1932x1932px. 45° field of view:
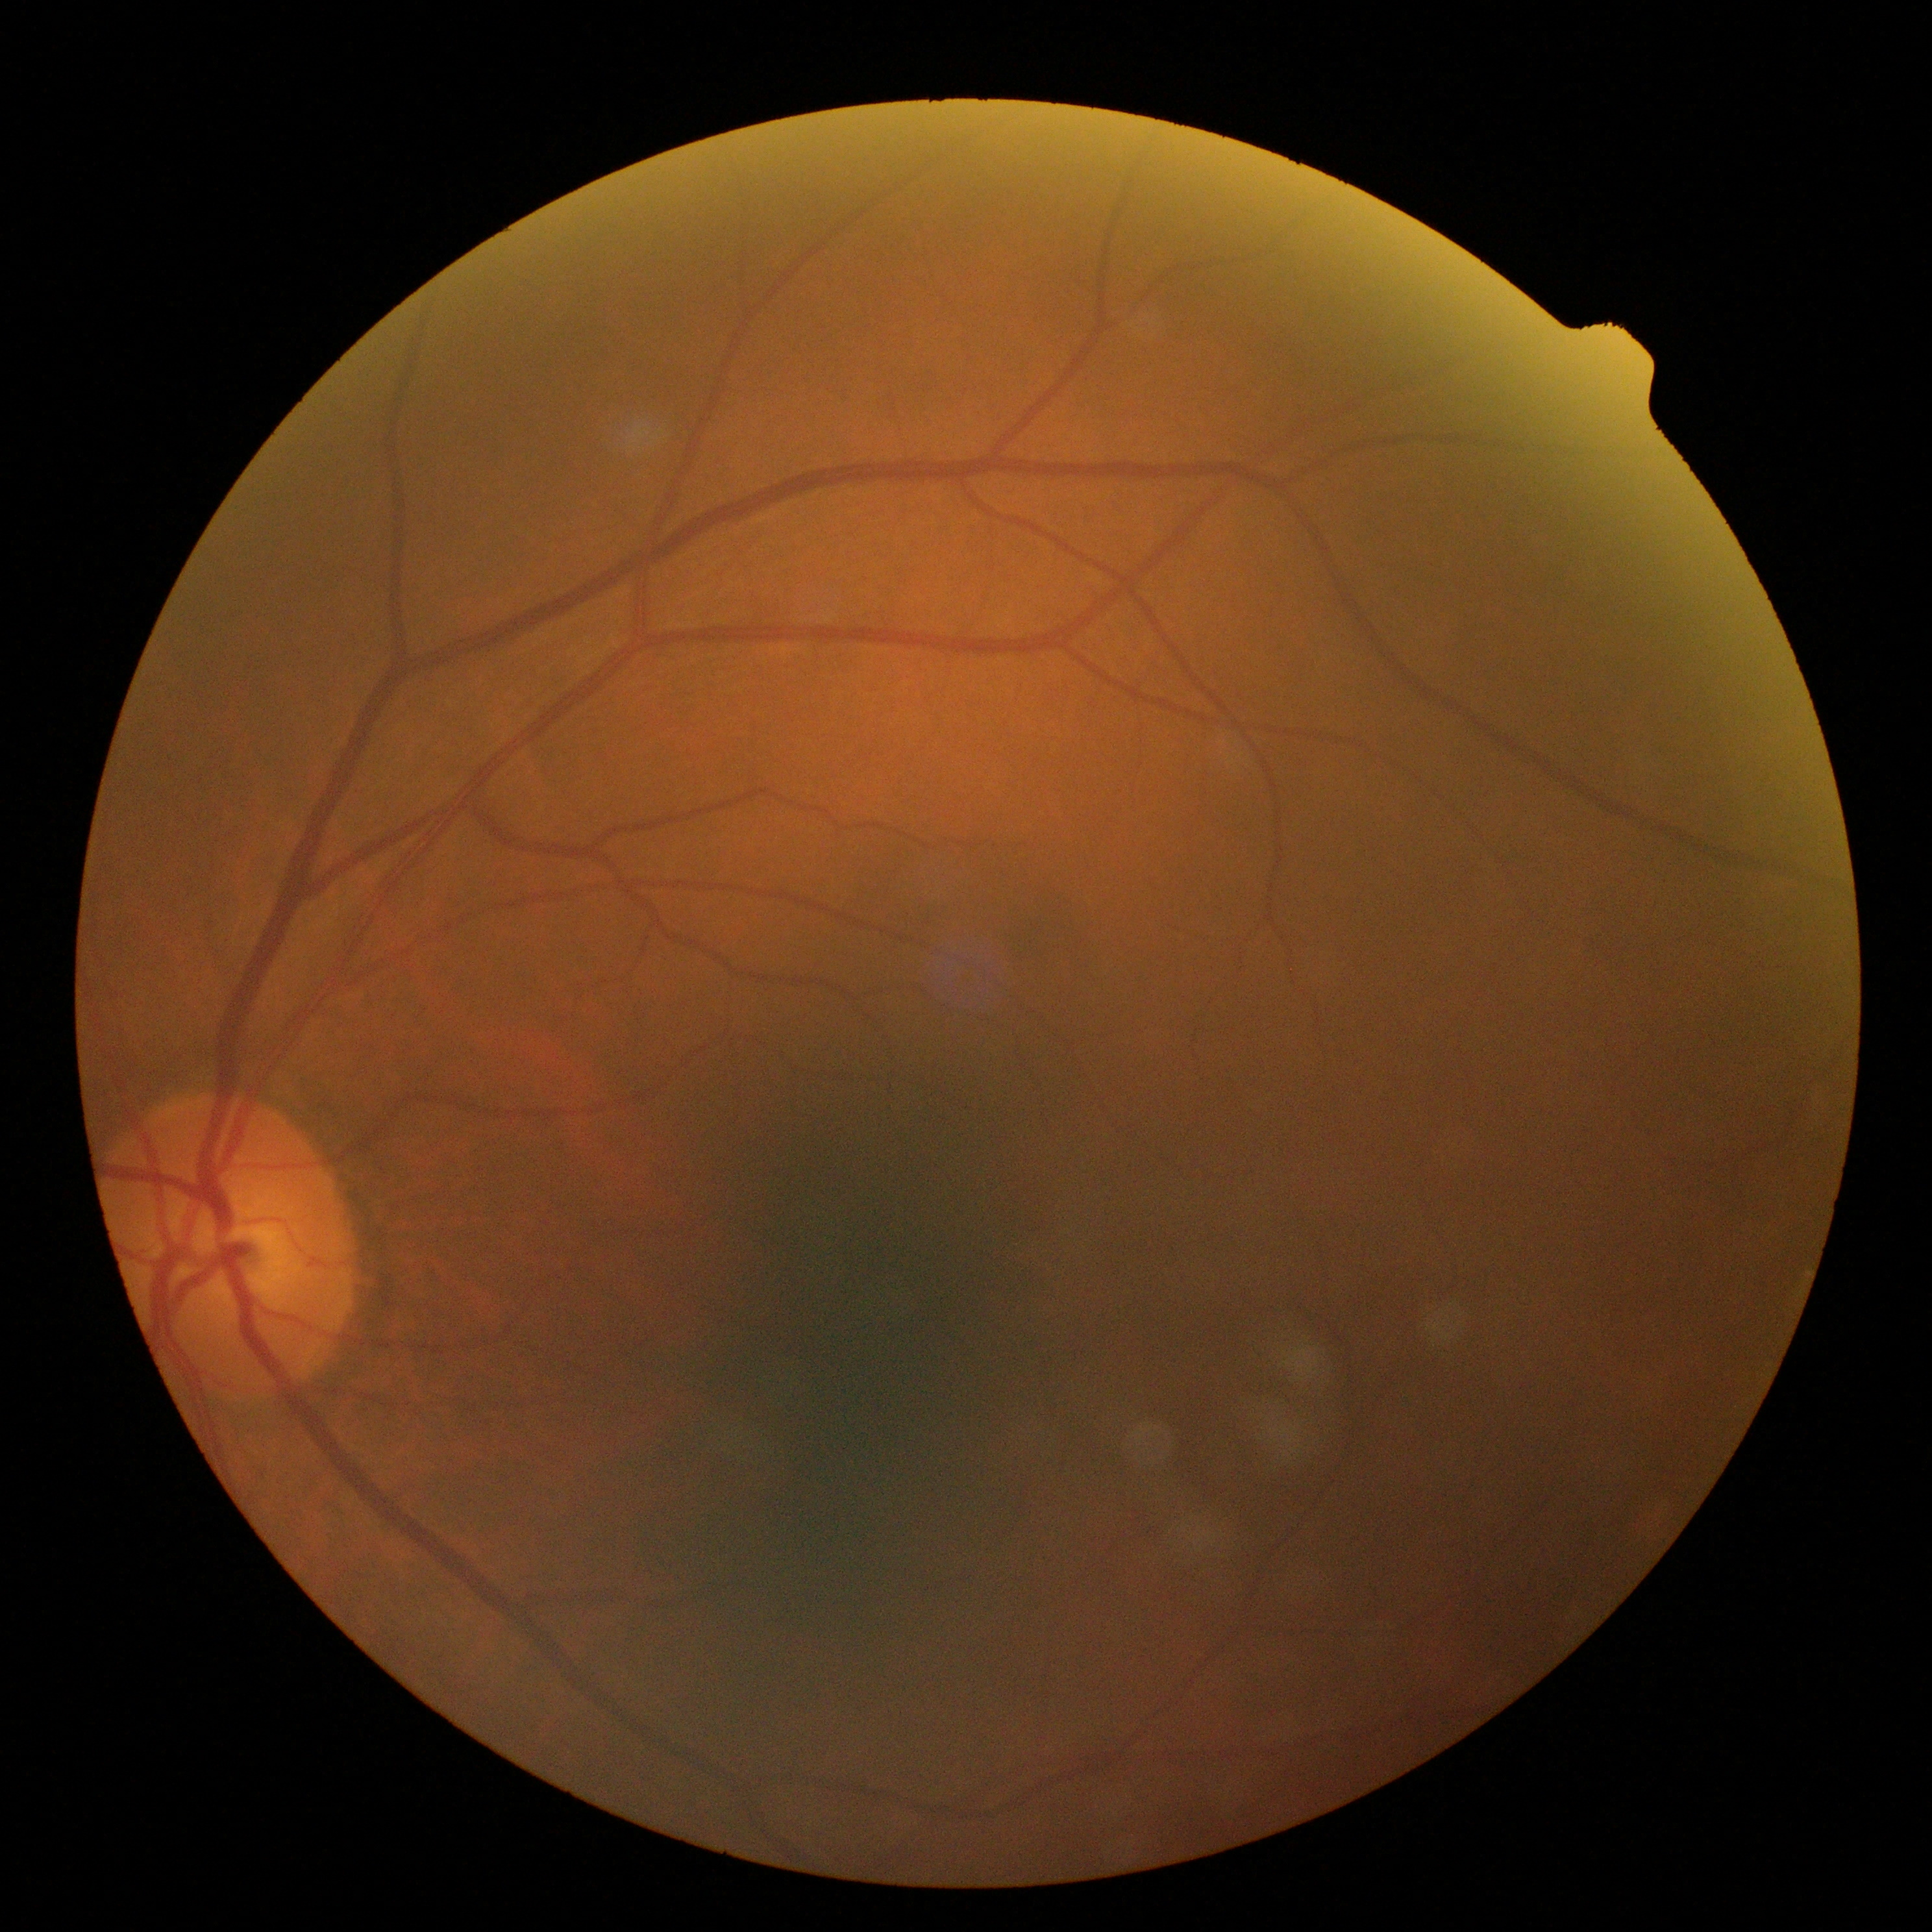 DR severity is grade 0 (no apparent retinopathy).